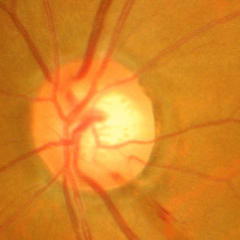 This fundus photograph shows advanced glaucoma.